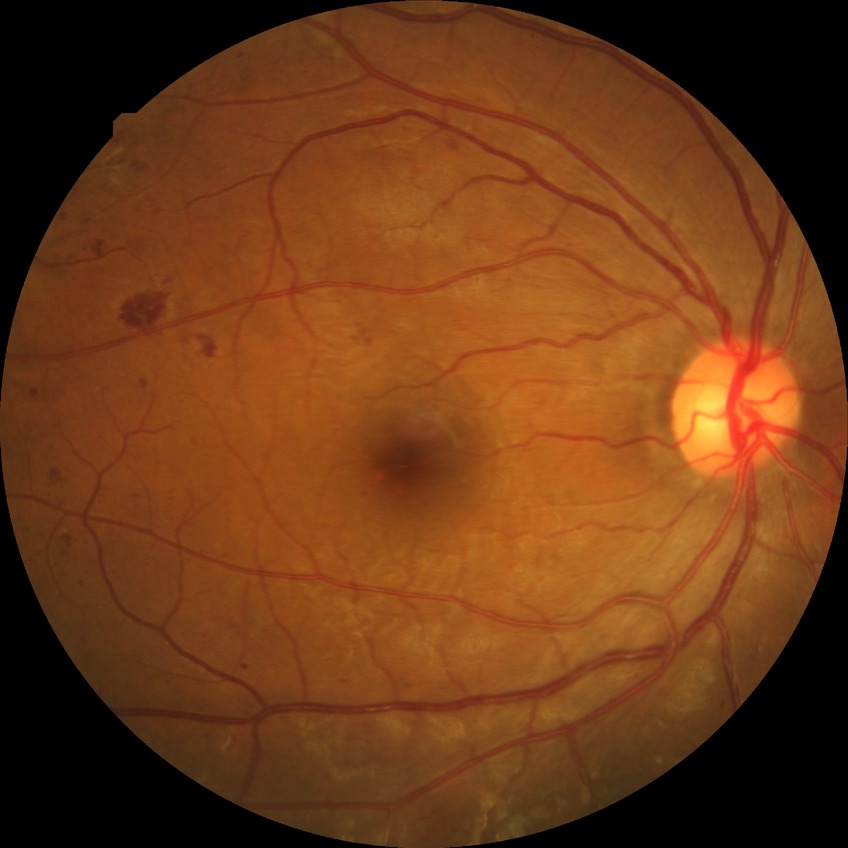

Diabetic retinopathy (DR): SDR (simple diabetic retinopathy).